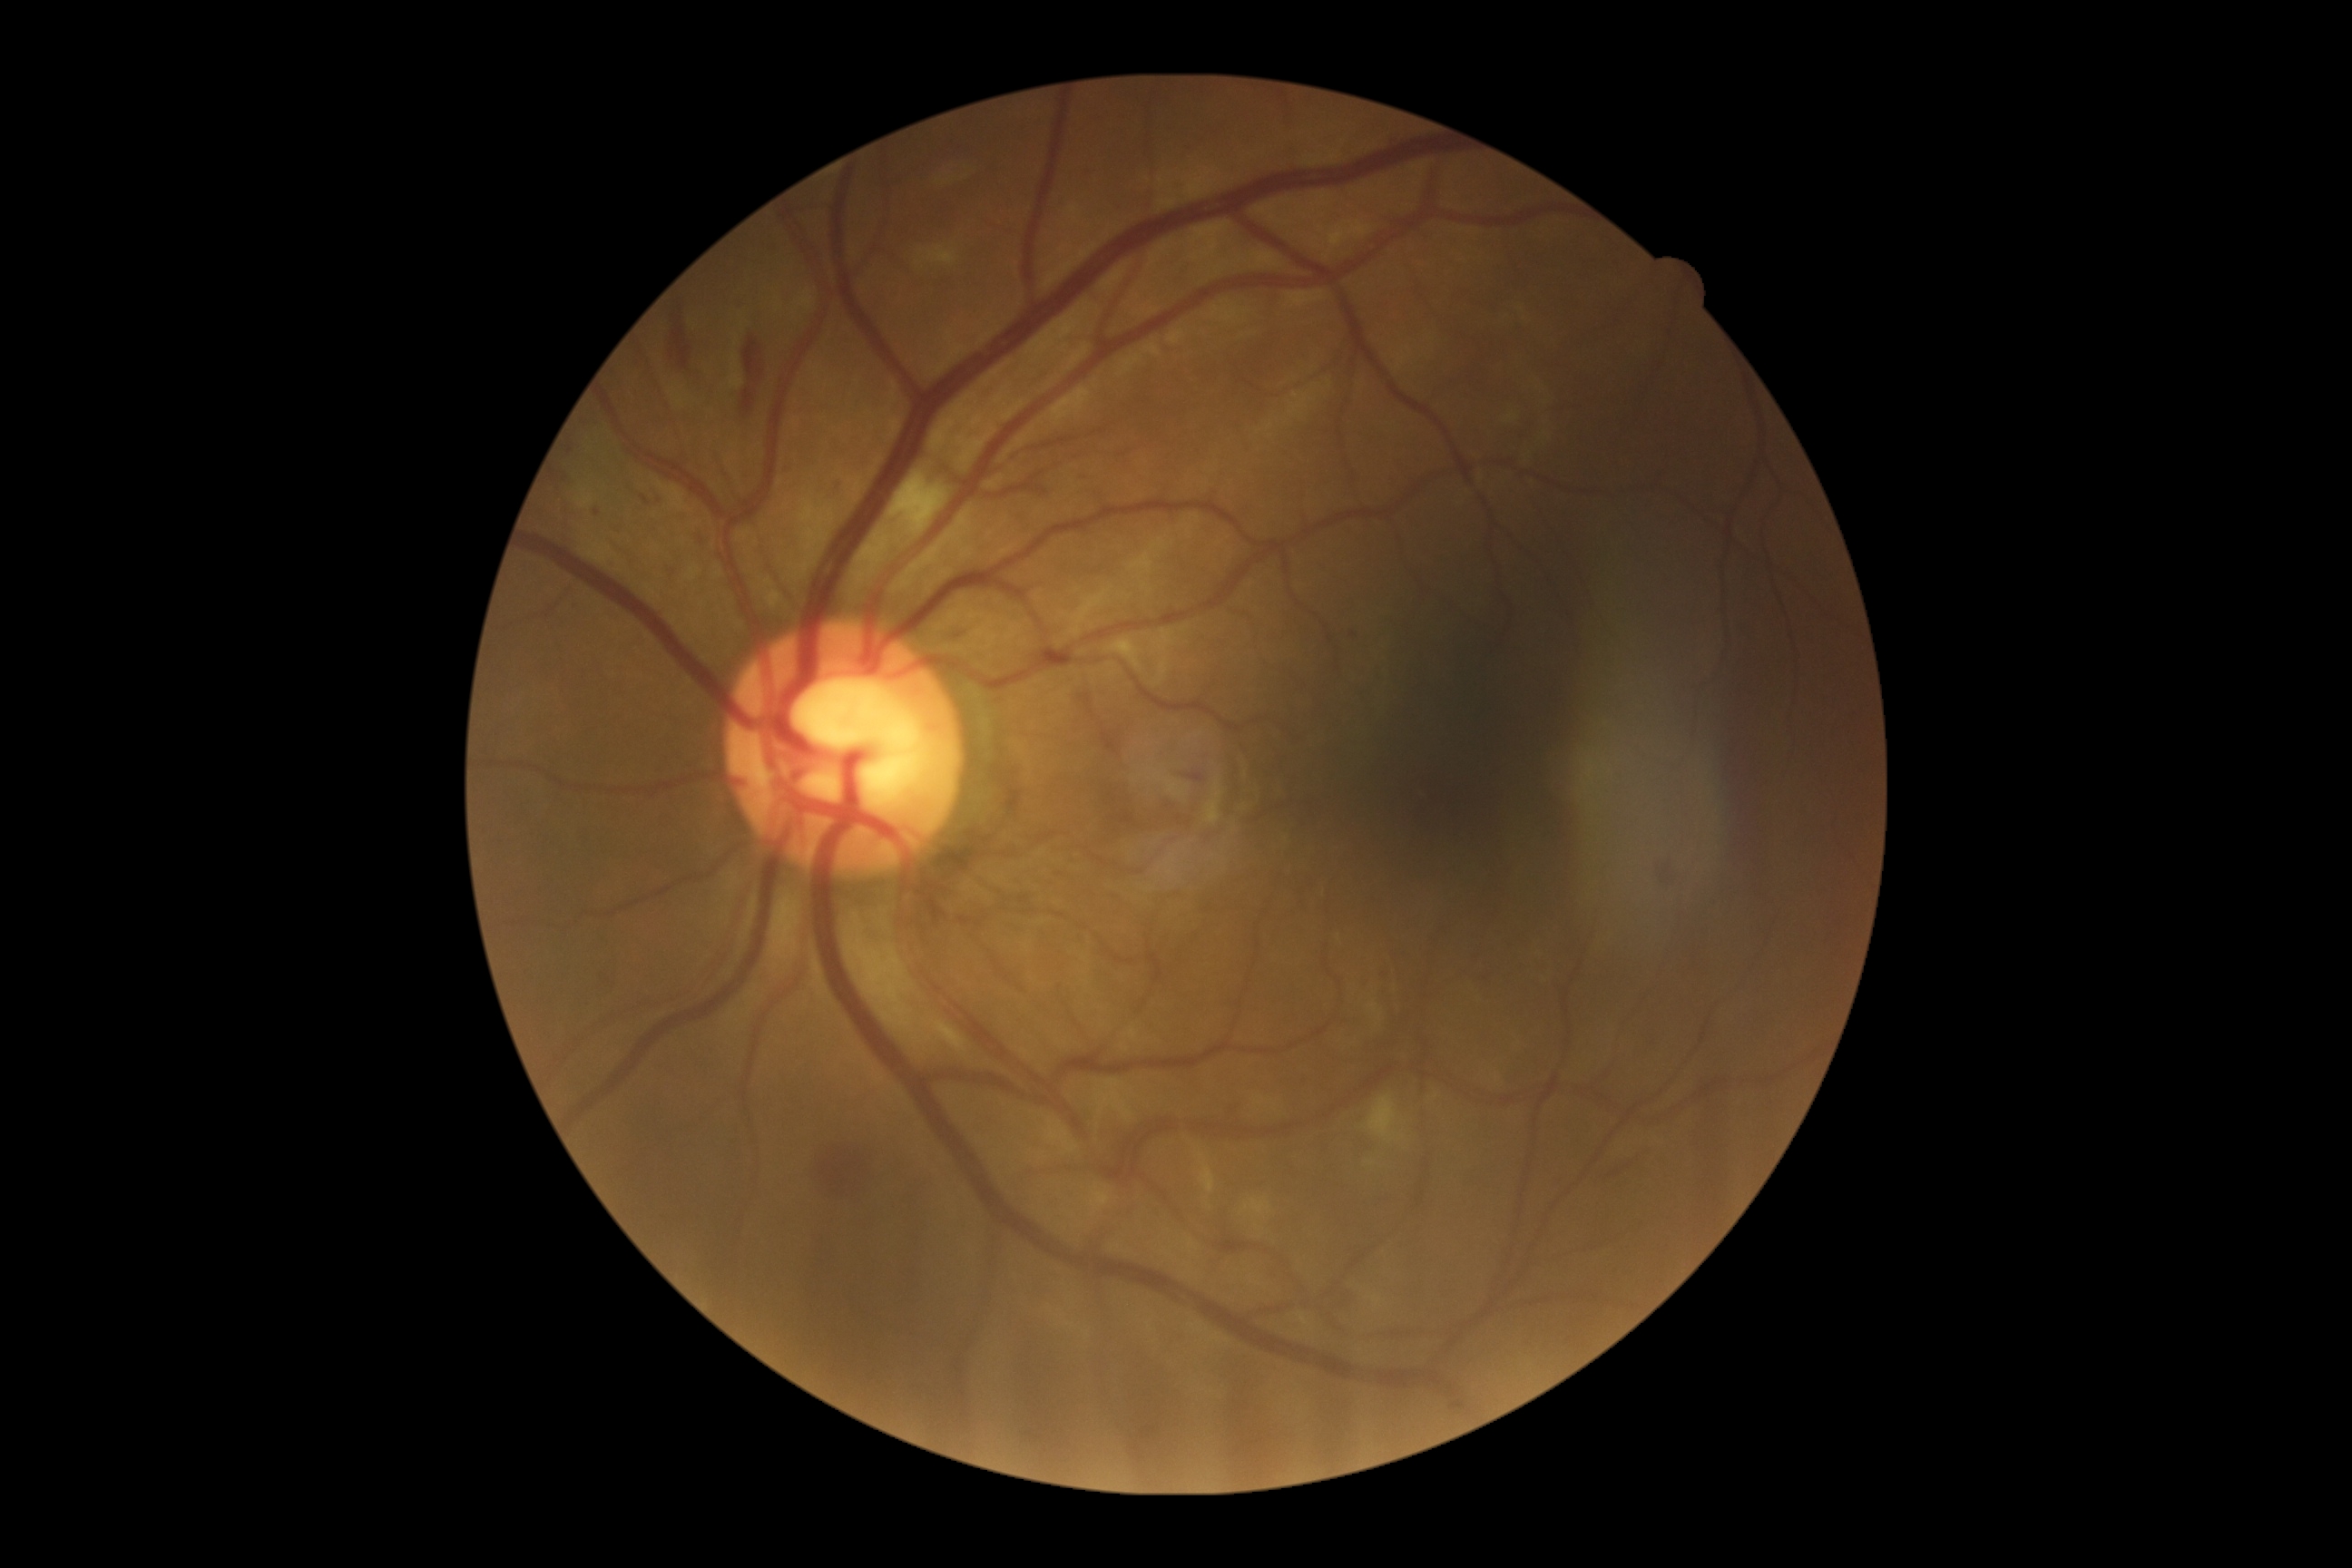
DR stage@moderate non-proliferative diabetic retinopathy (grade 2).